Non-mydriatic acquisition — 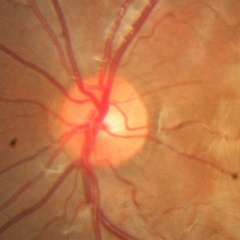 Showing no signs of glaucoma.